45° field of view · color fundus image
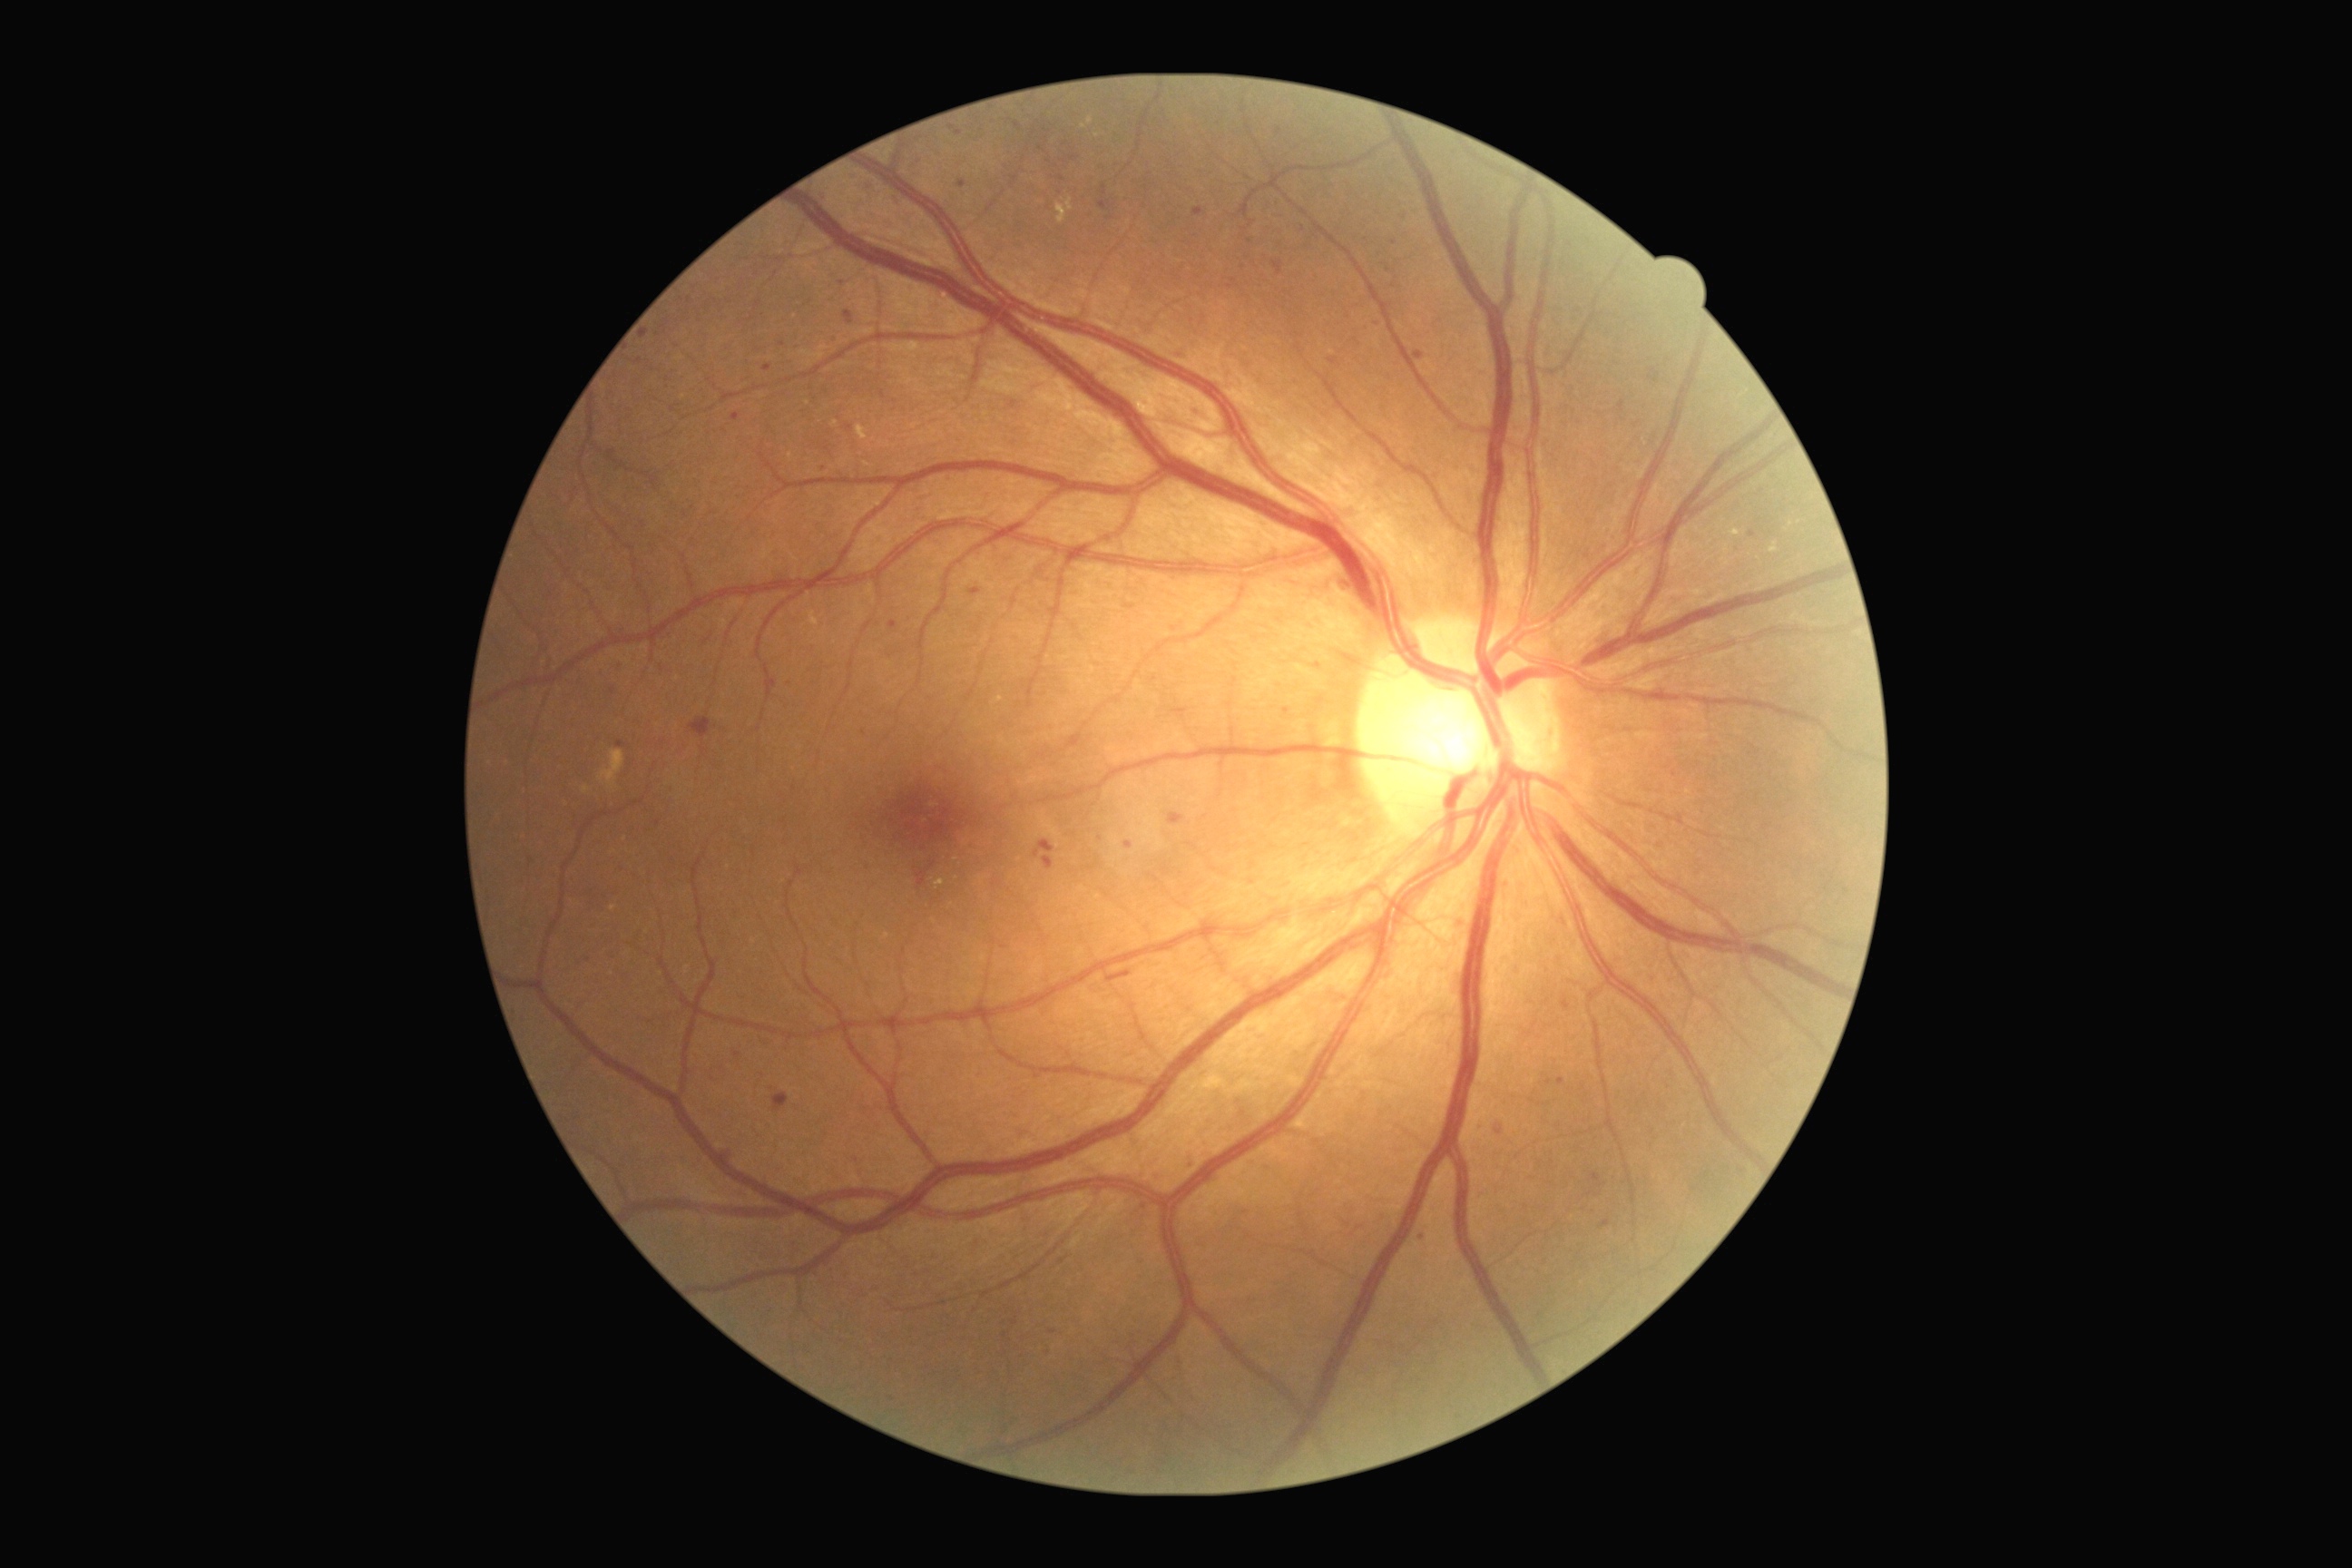
Diabetic retinopathy (DR) is grade 2.
Microaneurysms (MAs) include left=767, top=674, right=778, bottom=689; left=1600, top=1219, right=1611, bottom=1230; left=1750, top=531, right=1758, bottom=538; left=1188, top=1159, right=1195, bottom=1170; left=1496, top=1130, right=1504, bottom=1135; left=1649, top=377, right=1658, bottom=382; left=1620, top=402, right=1625, bottom=413; left=959, top=181, right=966, bottom=190; left=1415, top=351, right=1426, bottom=360; left=763, top=364, right=772, bottom=373.
Smaller MAs around x=1062 y=179; x=1013 y=405; x=1279 y=132; x=1675 y=775; x=825 y=469; x=620 y=744.